Wide-field contact fundus photograph of an infant: 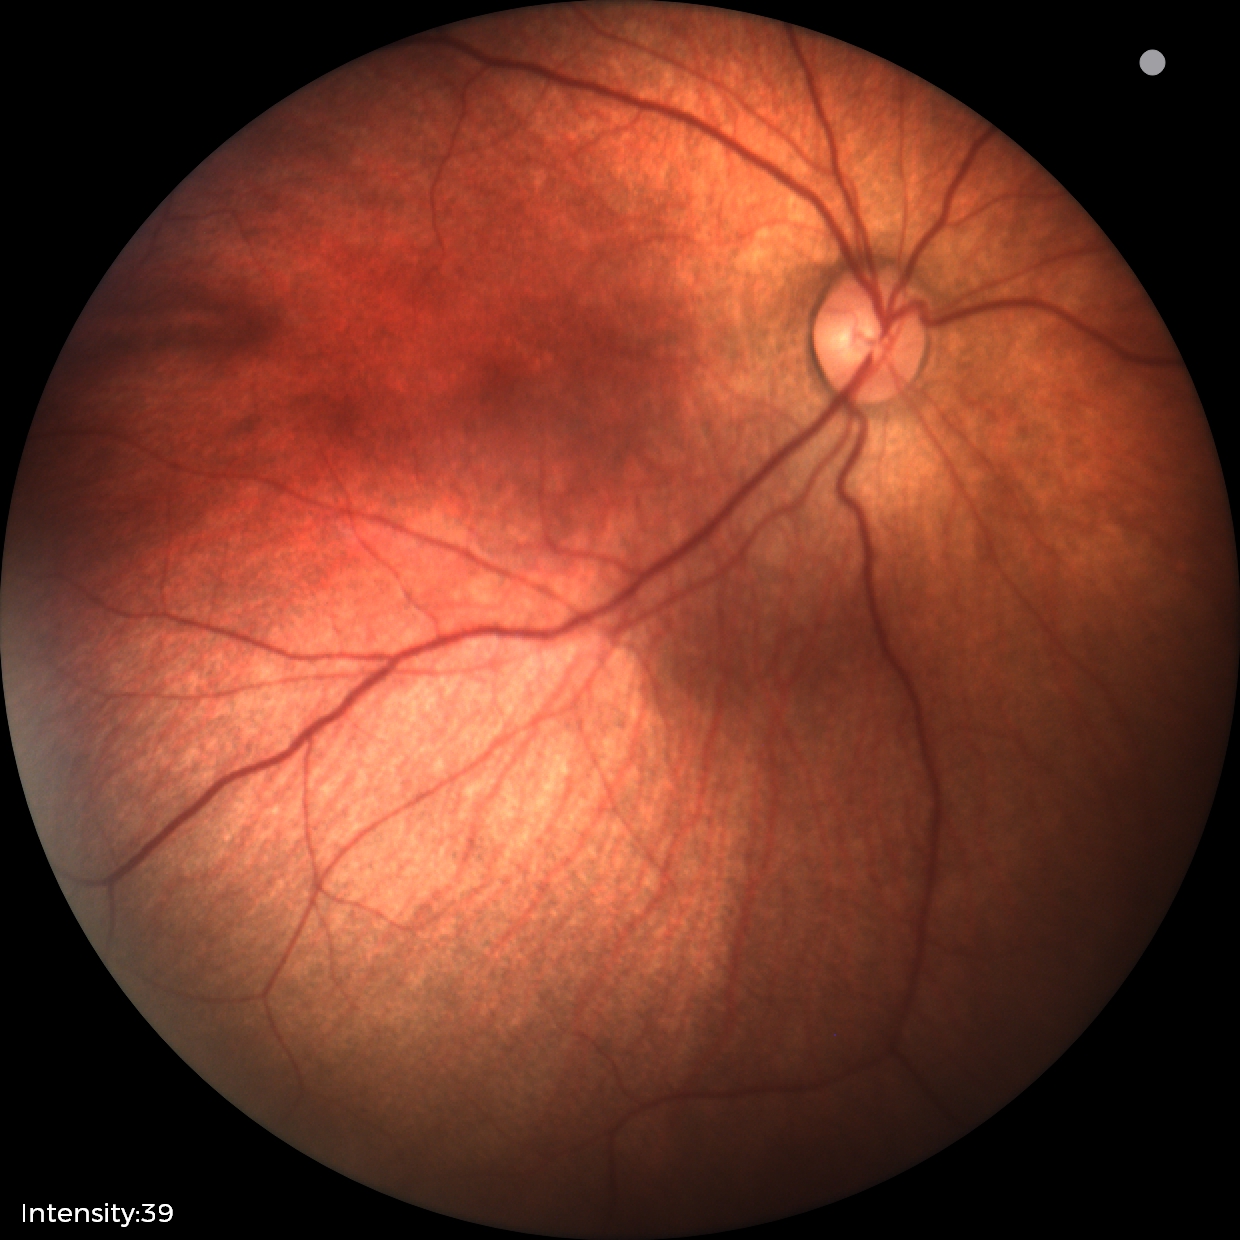 Normal screening examination.